Cropped to the optic nerve head, 240x240: 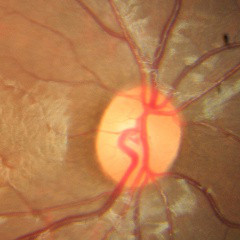

There is evidence of no glaucoma.